640 x 480 pixels; wide-field contact fundus photograph of an infant — 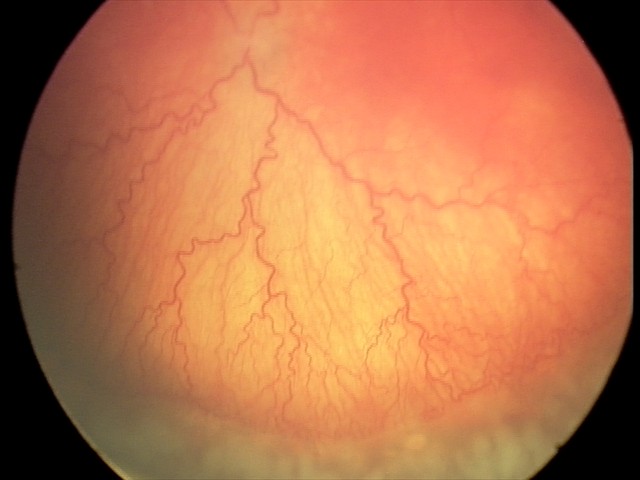
Assessment: aggressive retinopathy of prematurity
plus disease: present